Wide-field fundus photograph of an infant. Image size 640x480. Acquired on the Clarity RetCam 3.
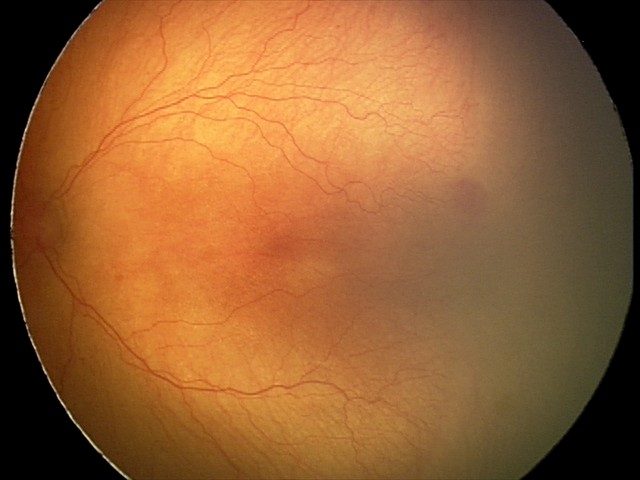 Series diagnosed as aggressive retinopathy of prematurity — rapidly progressive severe ROP with prominent plus disease, often without classic stage progression. Plus disease was diagnosed.